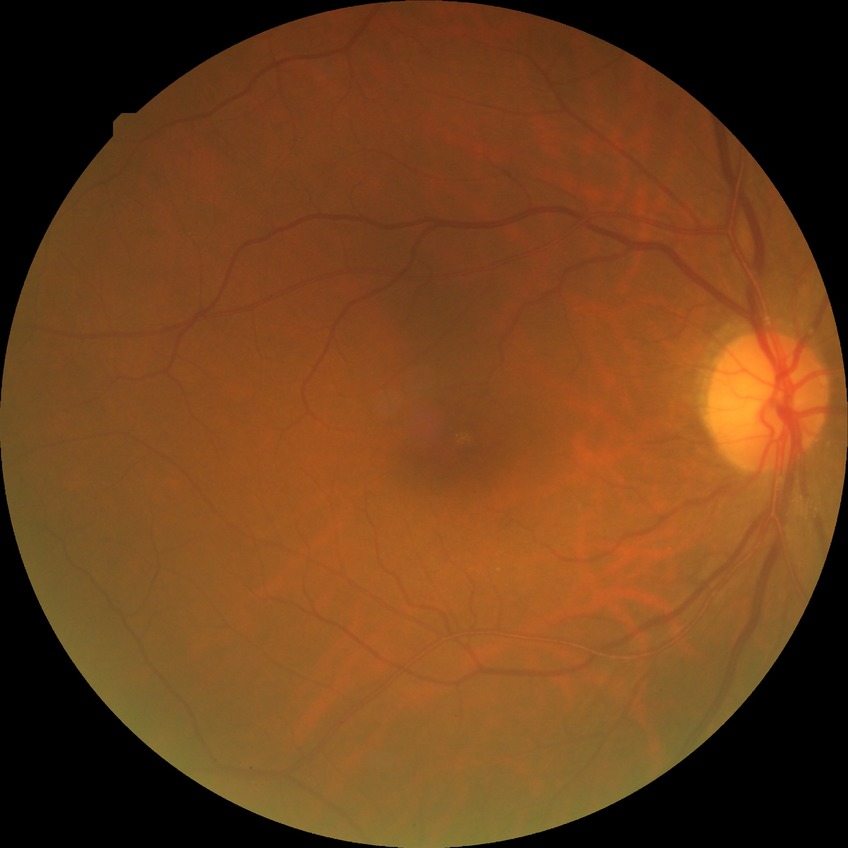
Diabetic retinopathy (DR): NDR (no diabetic retinopathy).